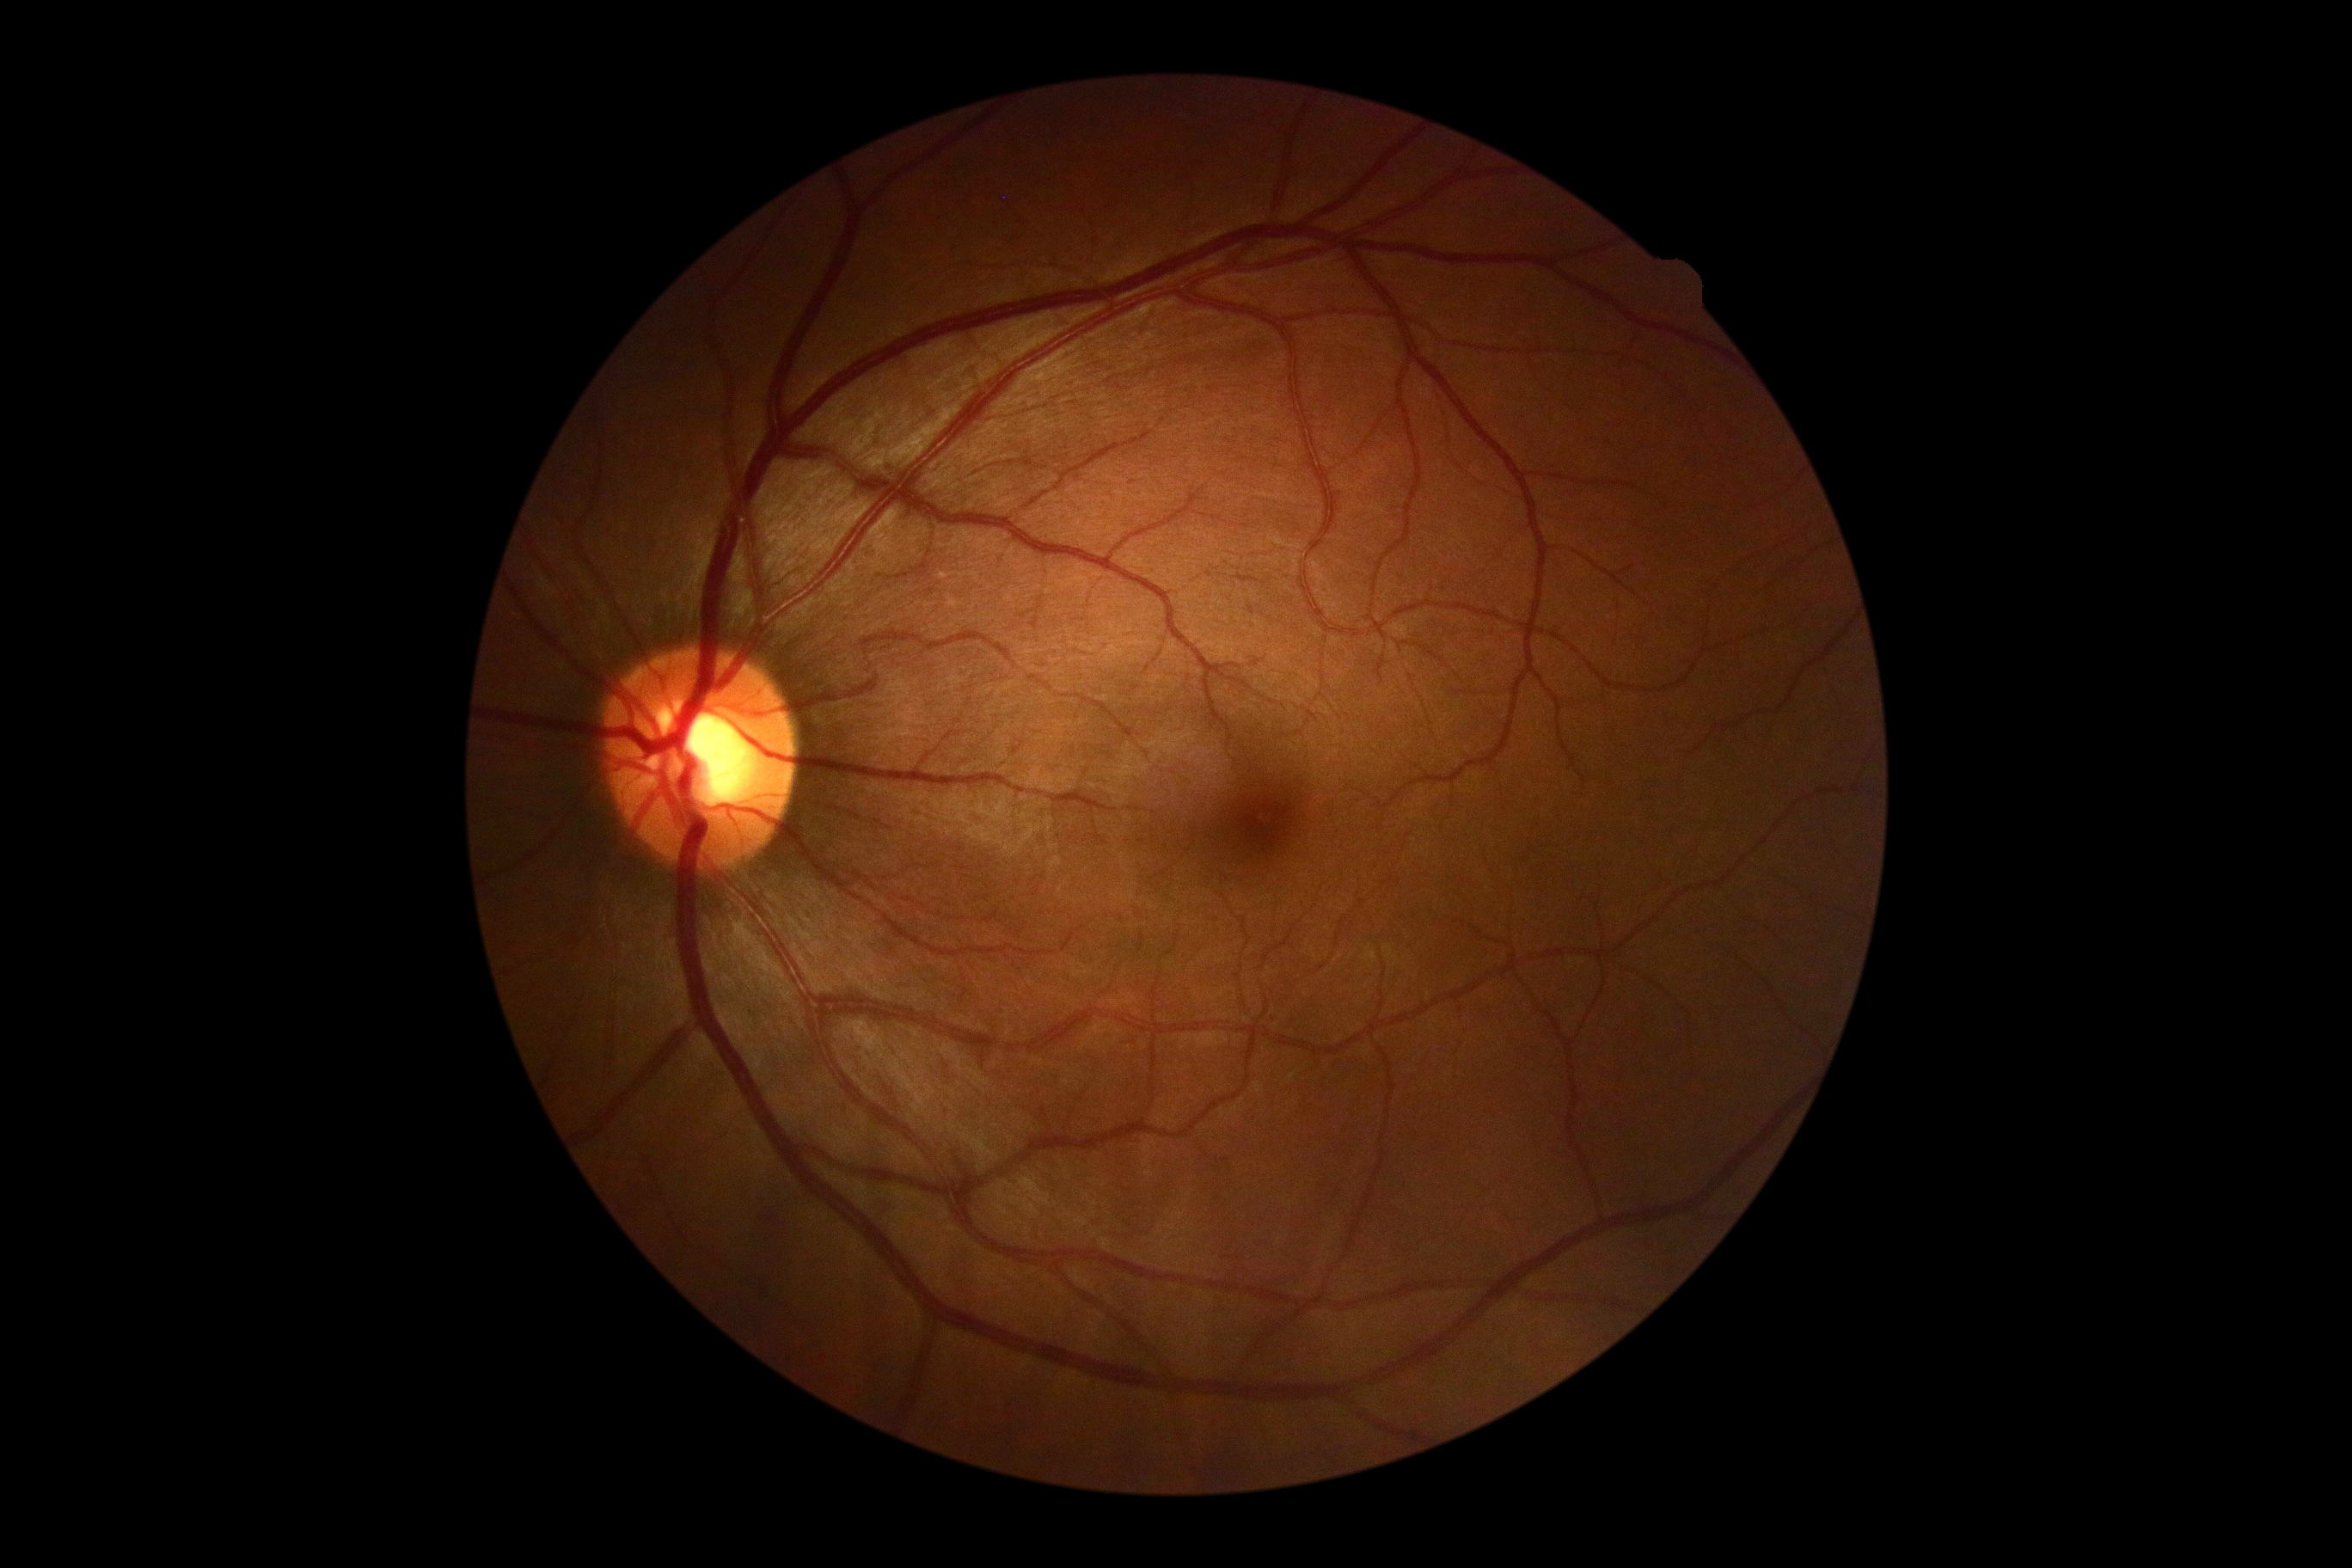
DR severity: grade 0 (no apparent retinopathy). No DR findings.